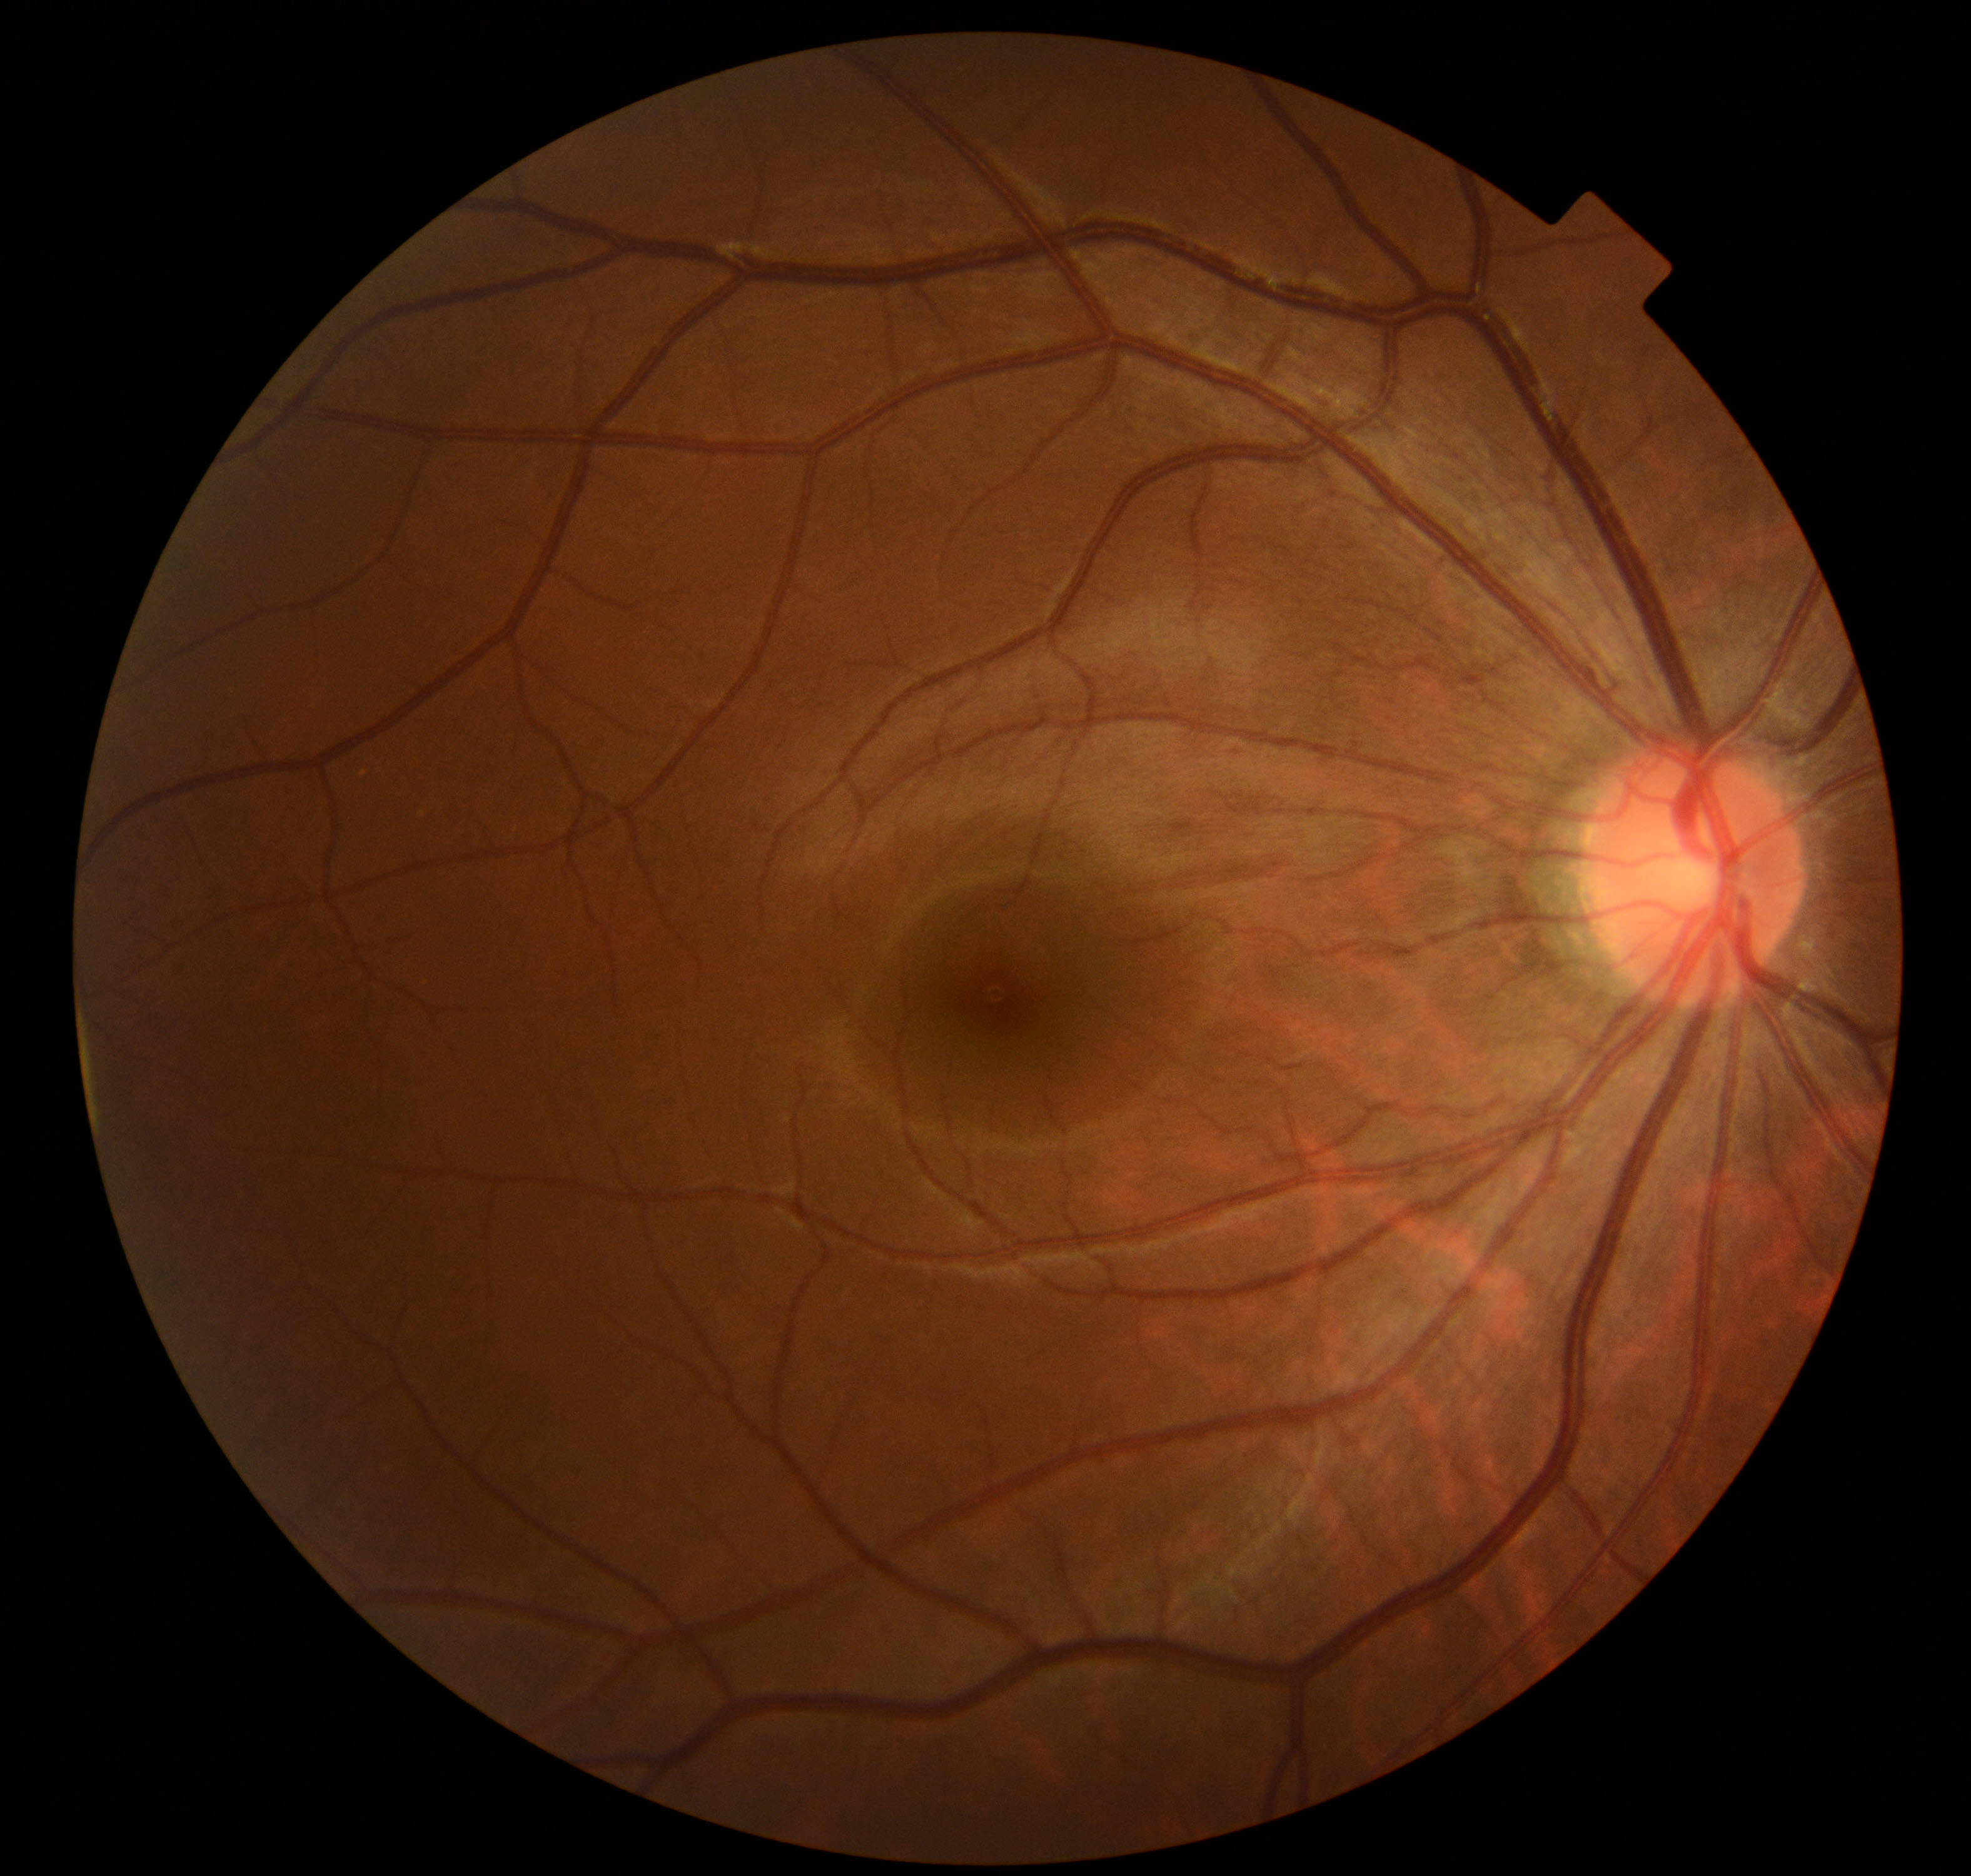 No abnormal findings on fundus examination.